Color fundus photograph centered on the optic disc. 574 x 574 pixels: 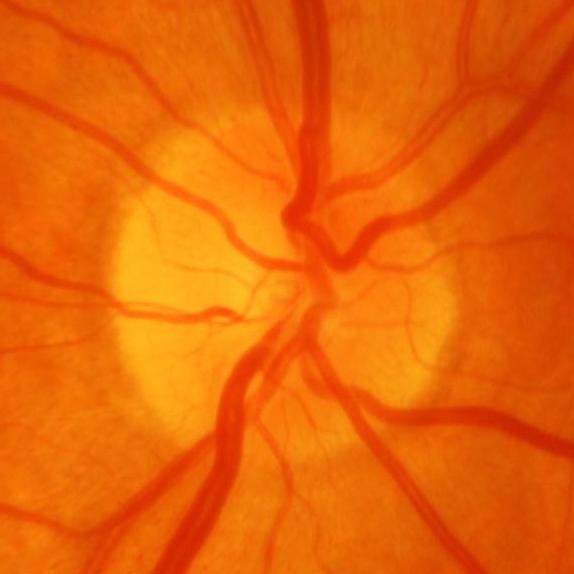 Diagnosis: glaucoma.